Color fundus image · 2352x1568 · 45-degree field of view
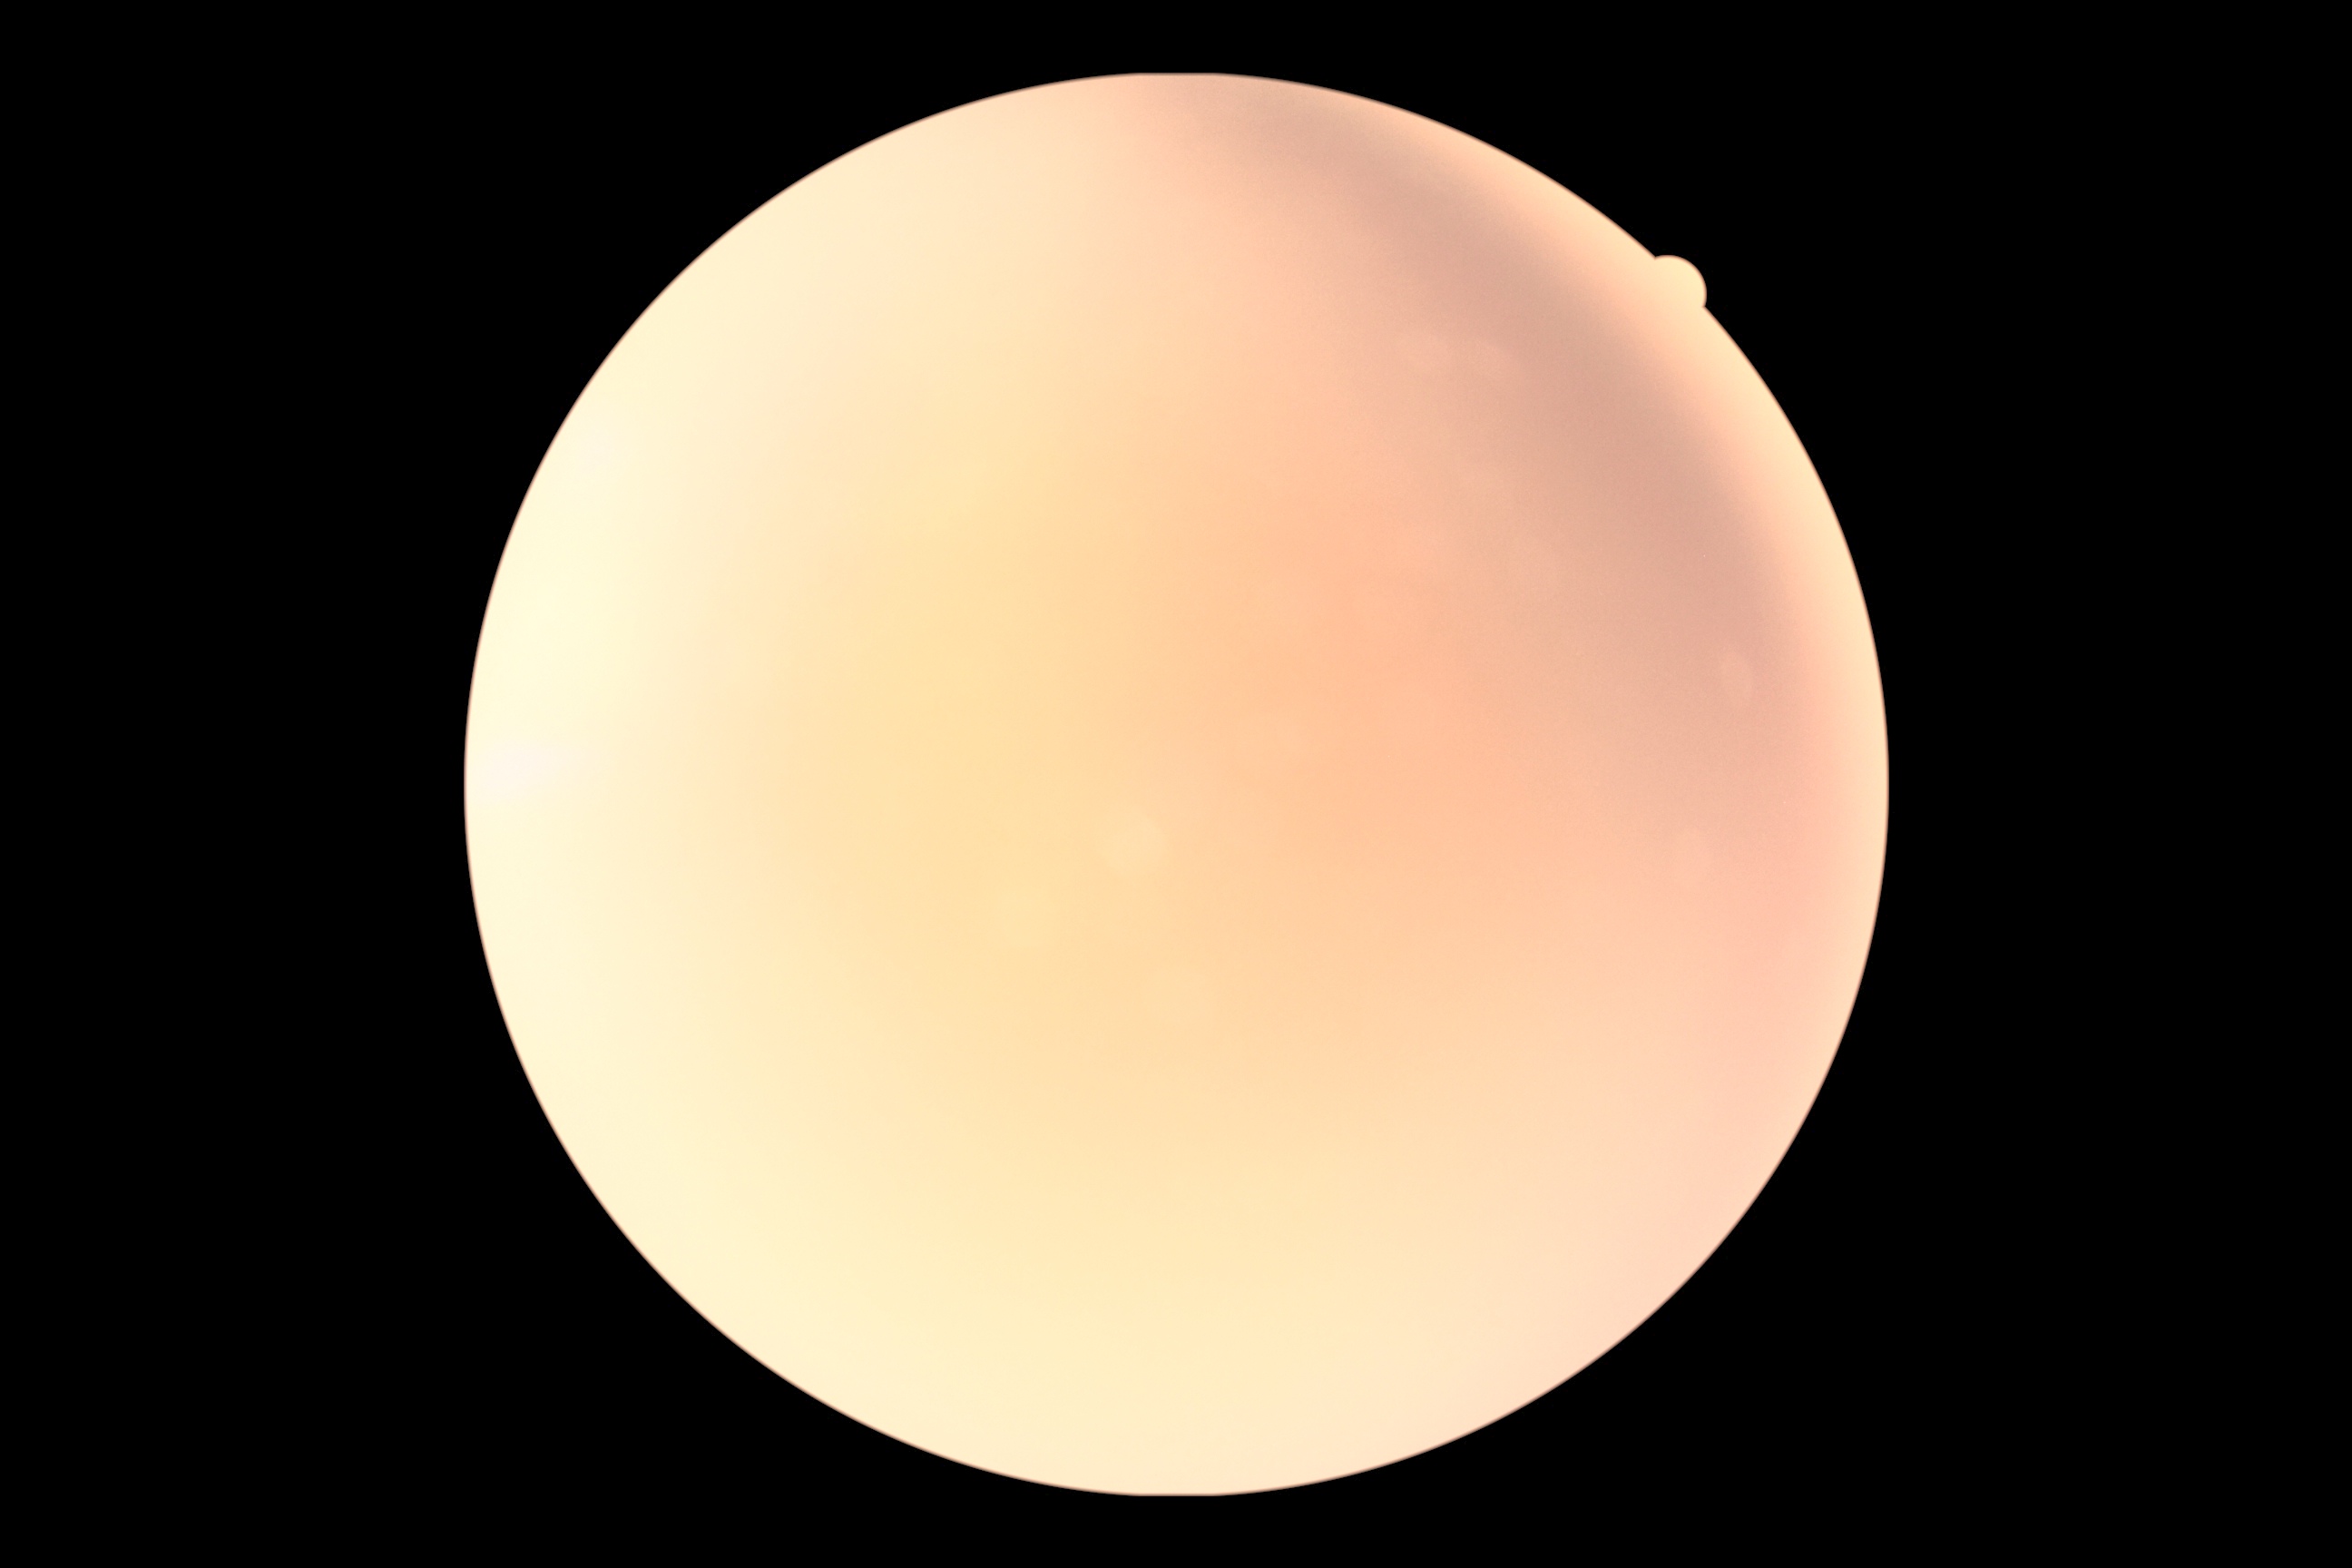
Diabetic retinopathy (DR) is ungradable due to poor image quality.